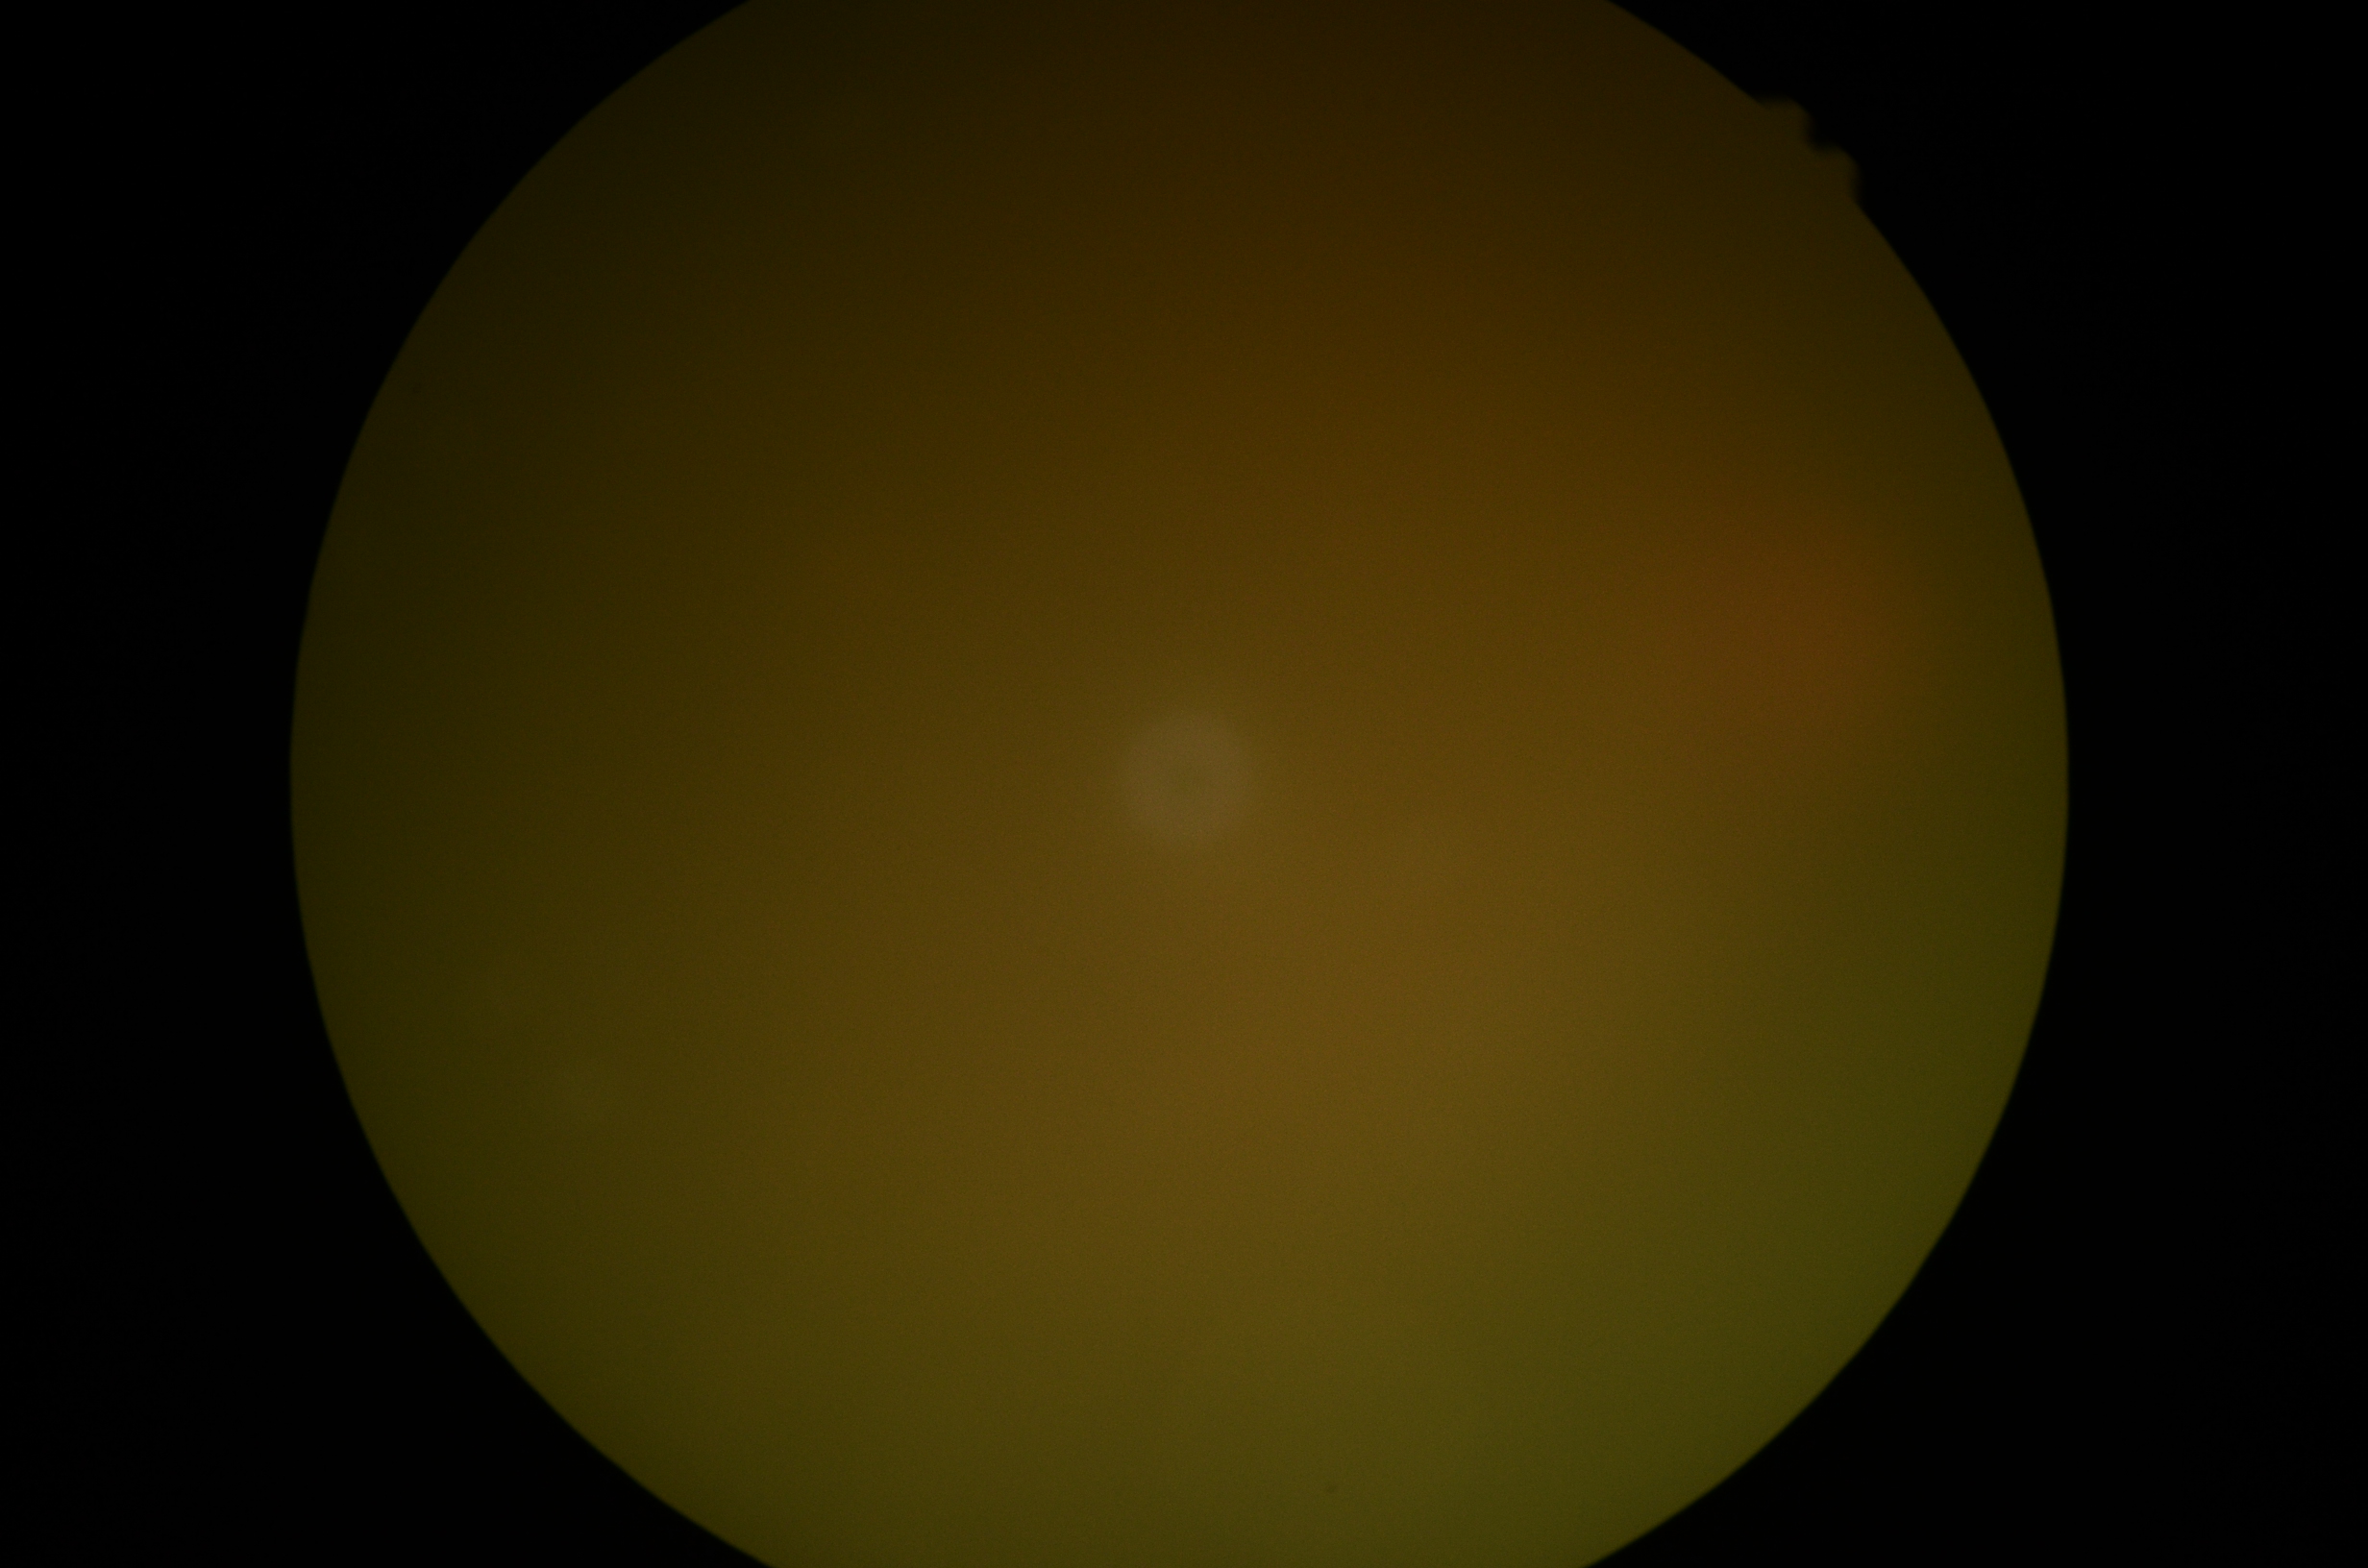 {
  "quality": "insufficient",
  "dr_grade": "ungradable due to poor image quality"
}